Color fundus photograph; 240 by 240 pixels:
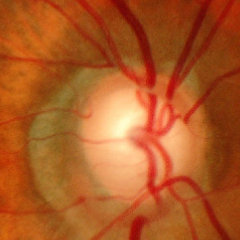

Glaucoma assessment: advanced glaucomatous optic neuropathy.